RetCam wide-field infant fundus image.
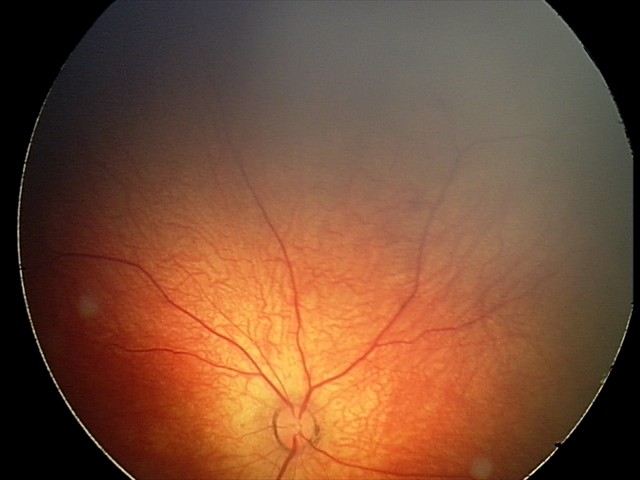
Screening series with retinal hemorrhages.